45-degree field of view: 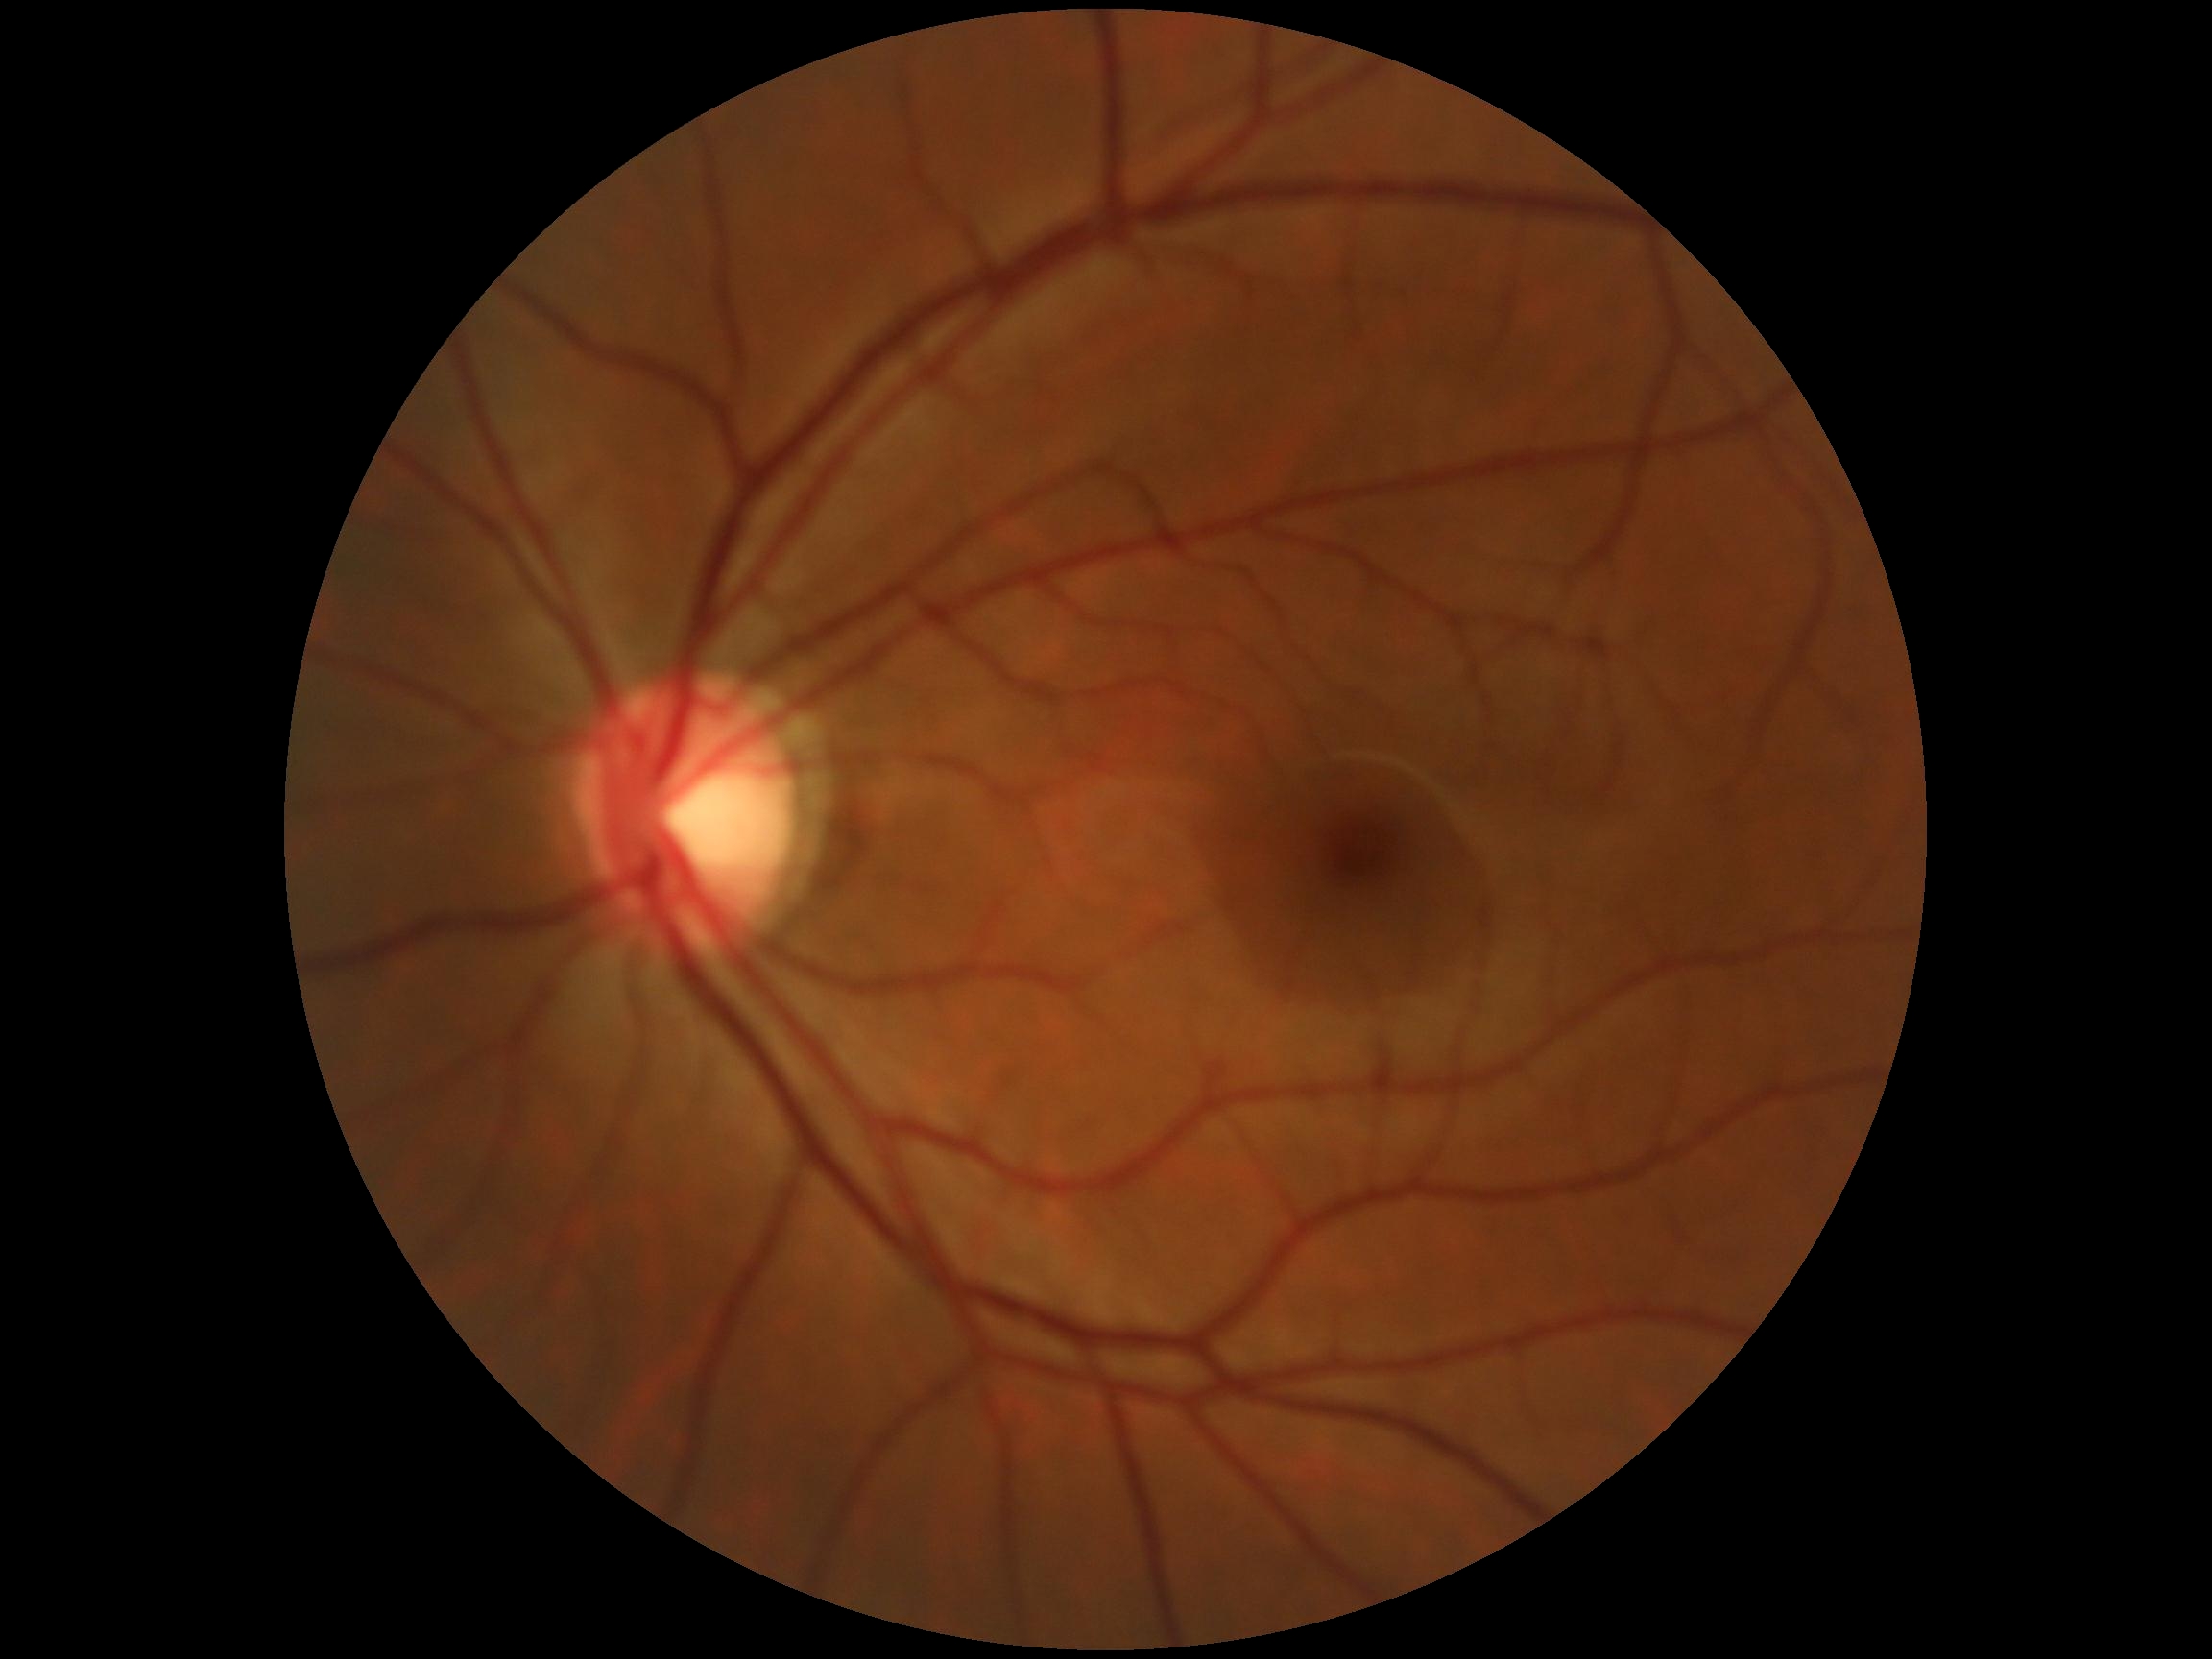
DR stage: grade 0 (no apparent retinopathy) | DR impression: no DR findings.